Camera: NIDEK AFC-230. 848 by 848 pixels. Nonmydriatic: 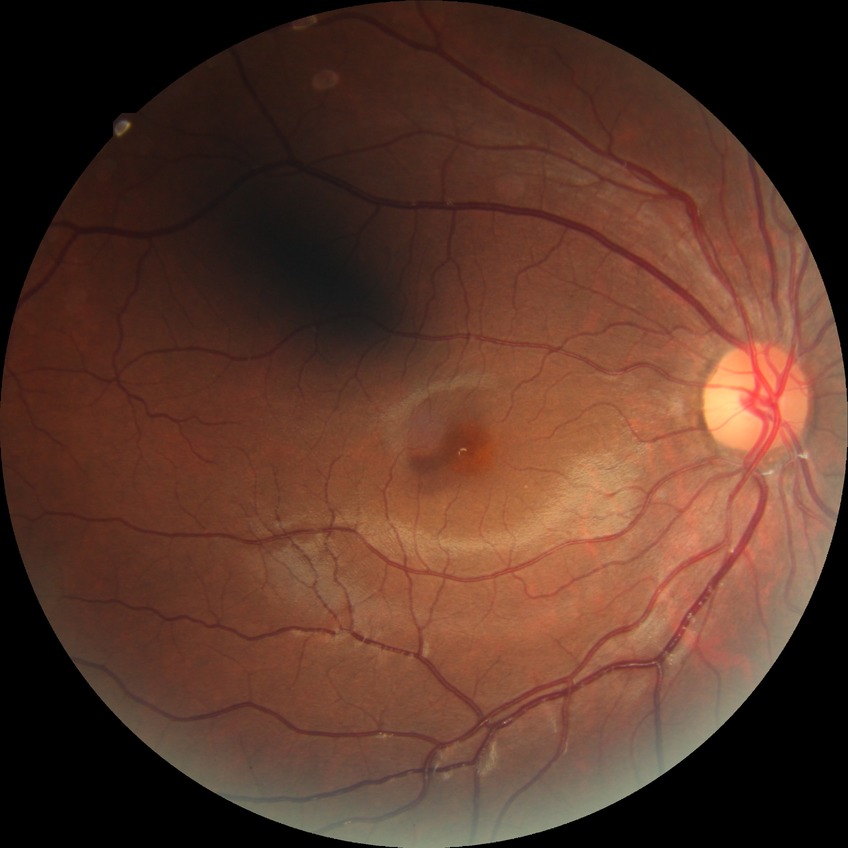 {"davis_grade": "no diabetic retinopathy"}